1932x1932px. 45° field of view.
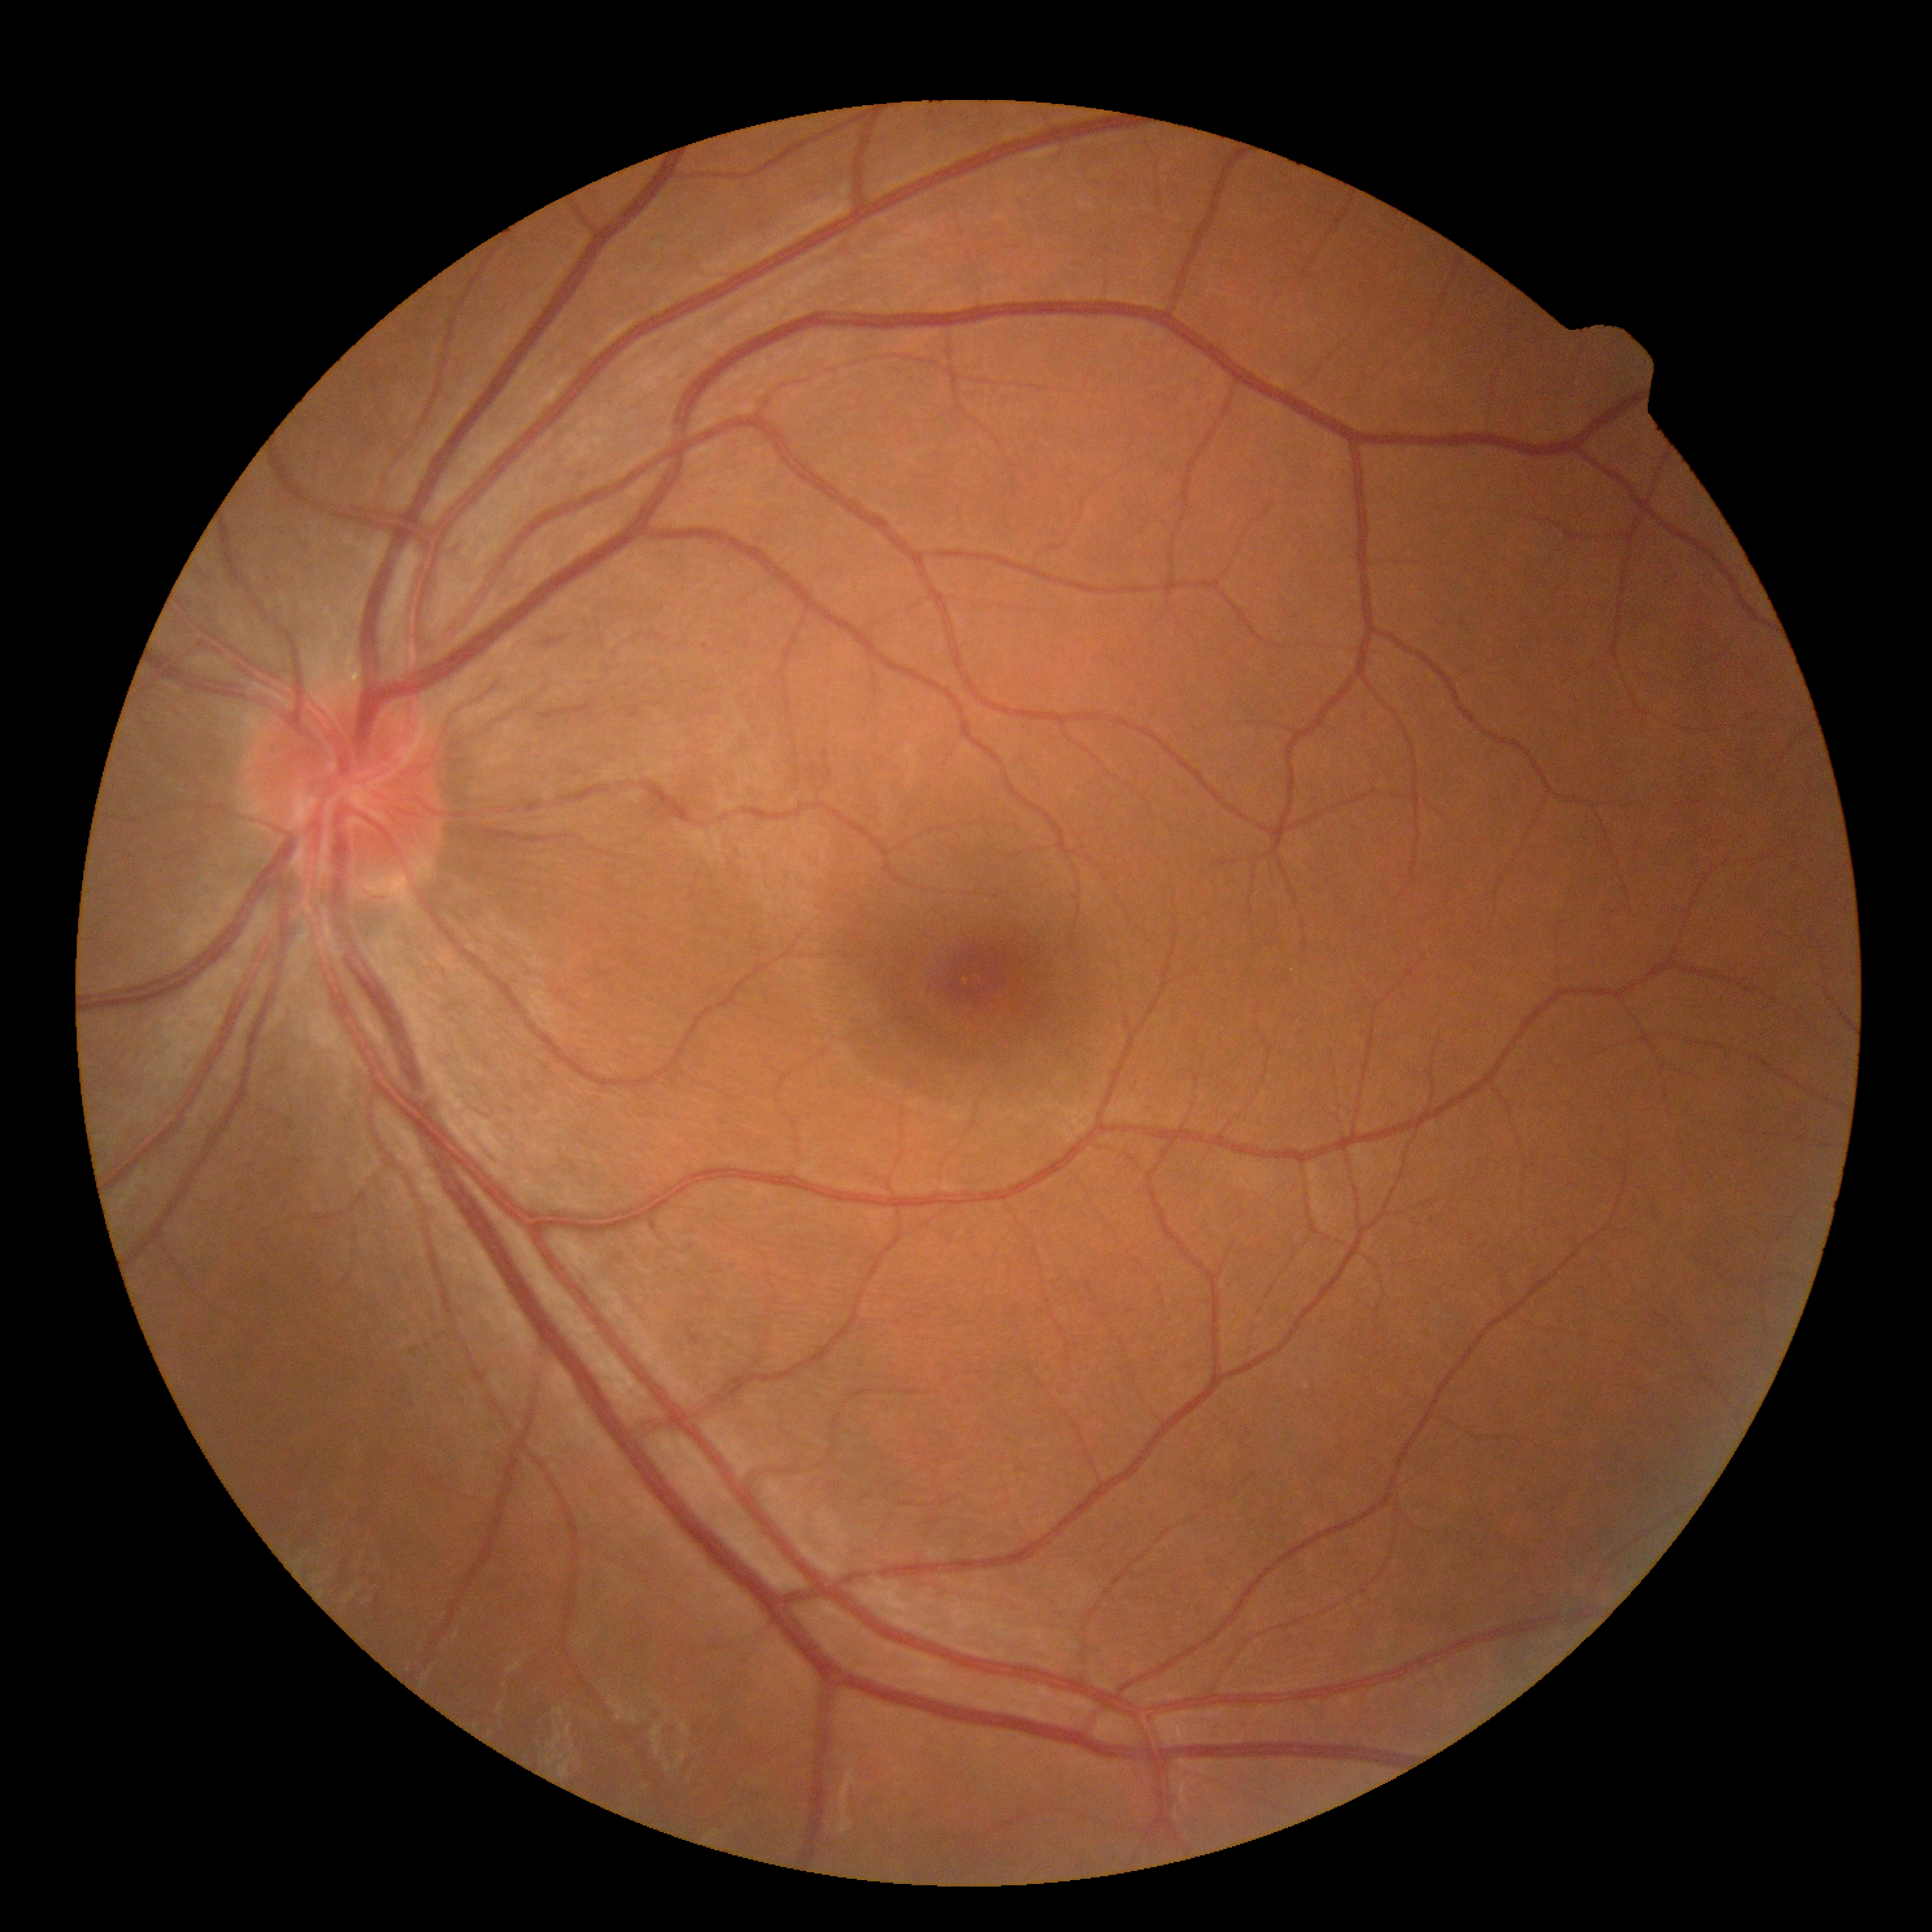
diabetic retinopathy severity@grade 0.